Without pupil dilation; modified Davis classification; color fundus image: 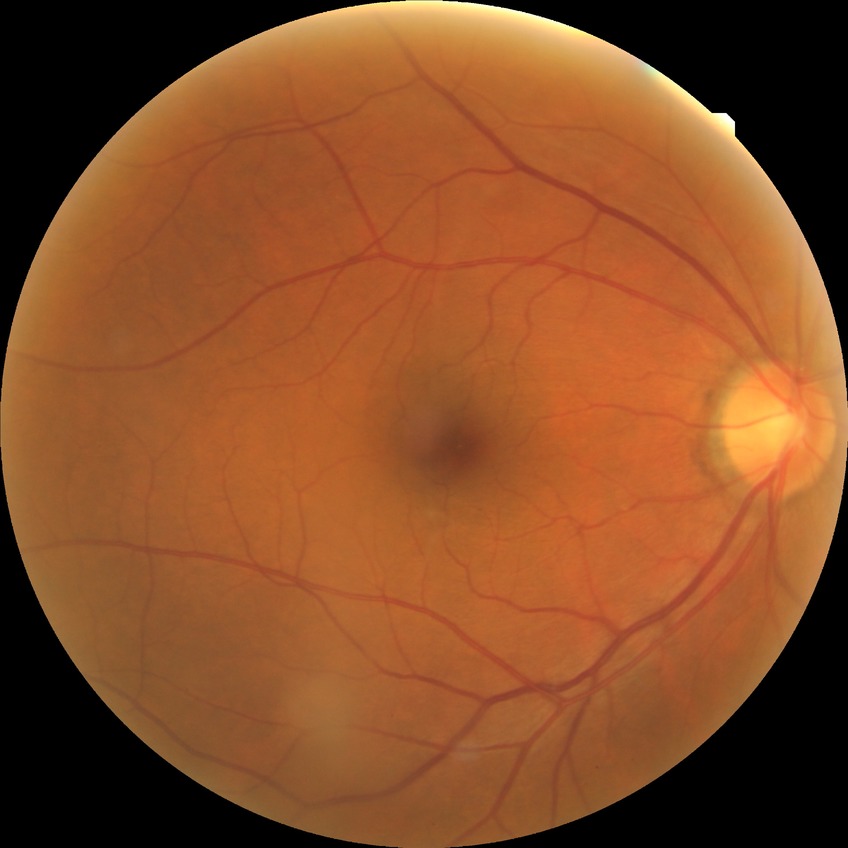

DR stage is NDR.